2346x1568px; color fundus image — 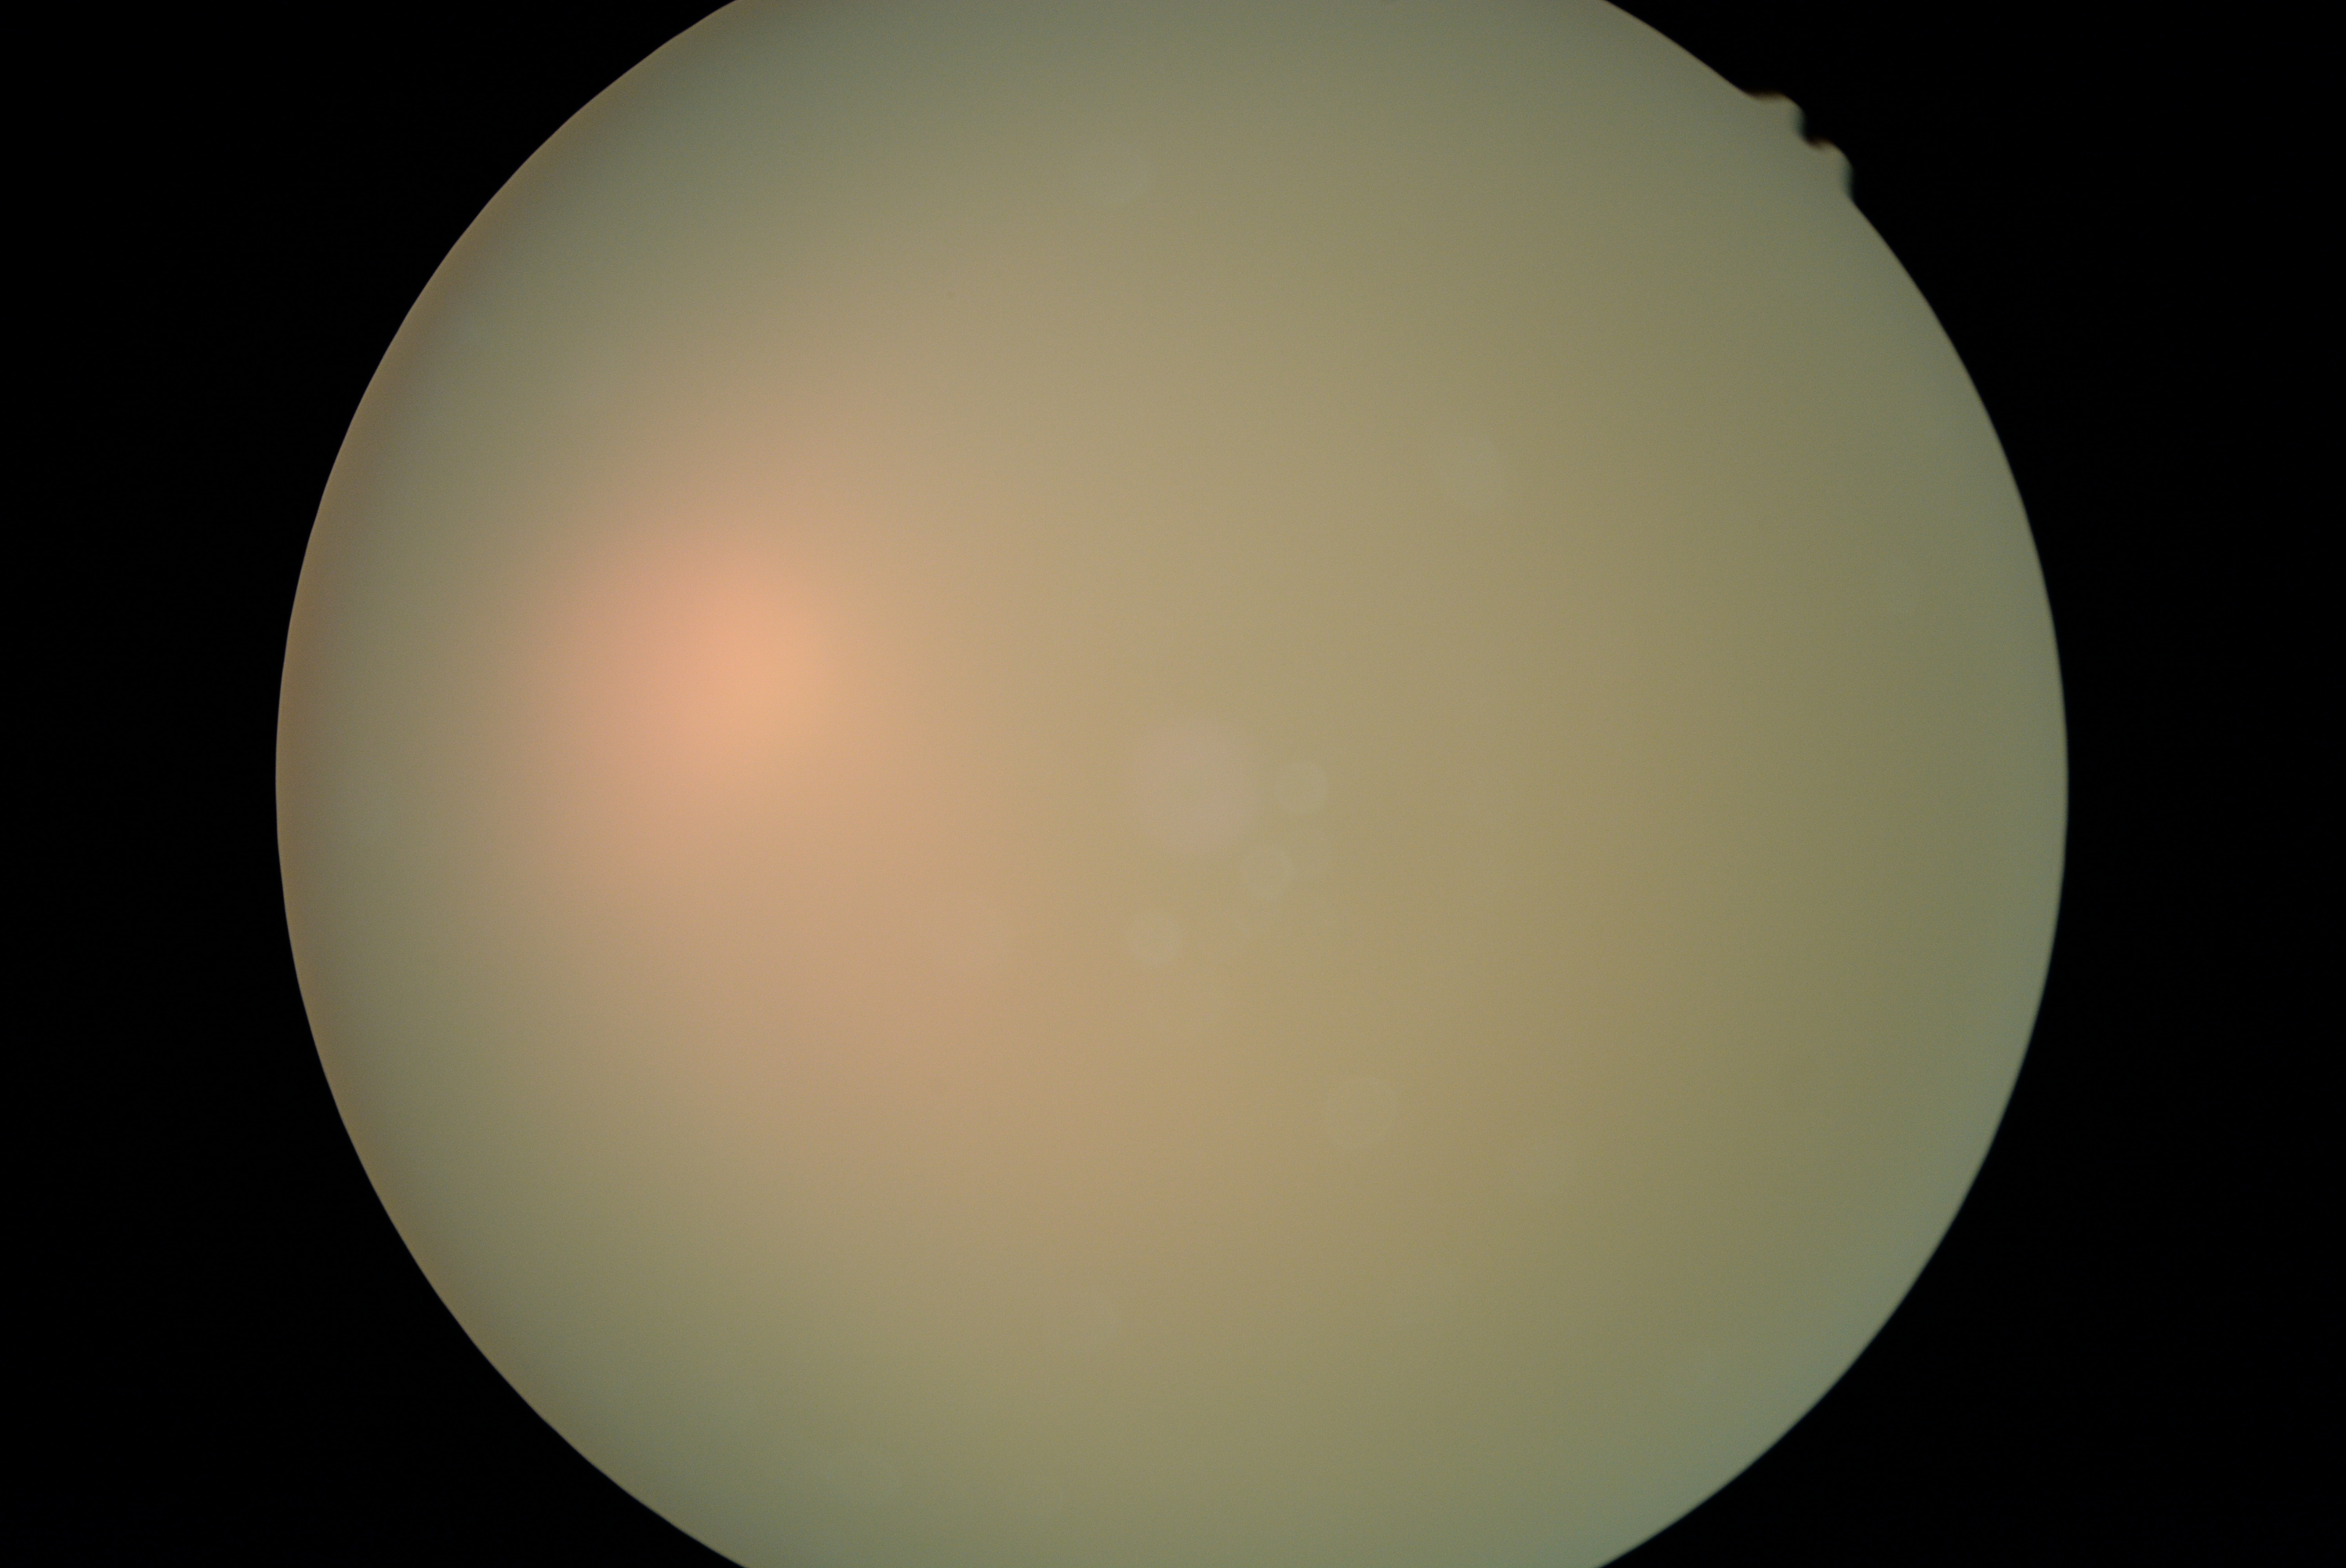 Ungradable image — DR severity cannot be determined. DR: ungradable due to poor image quality.